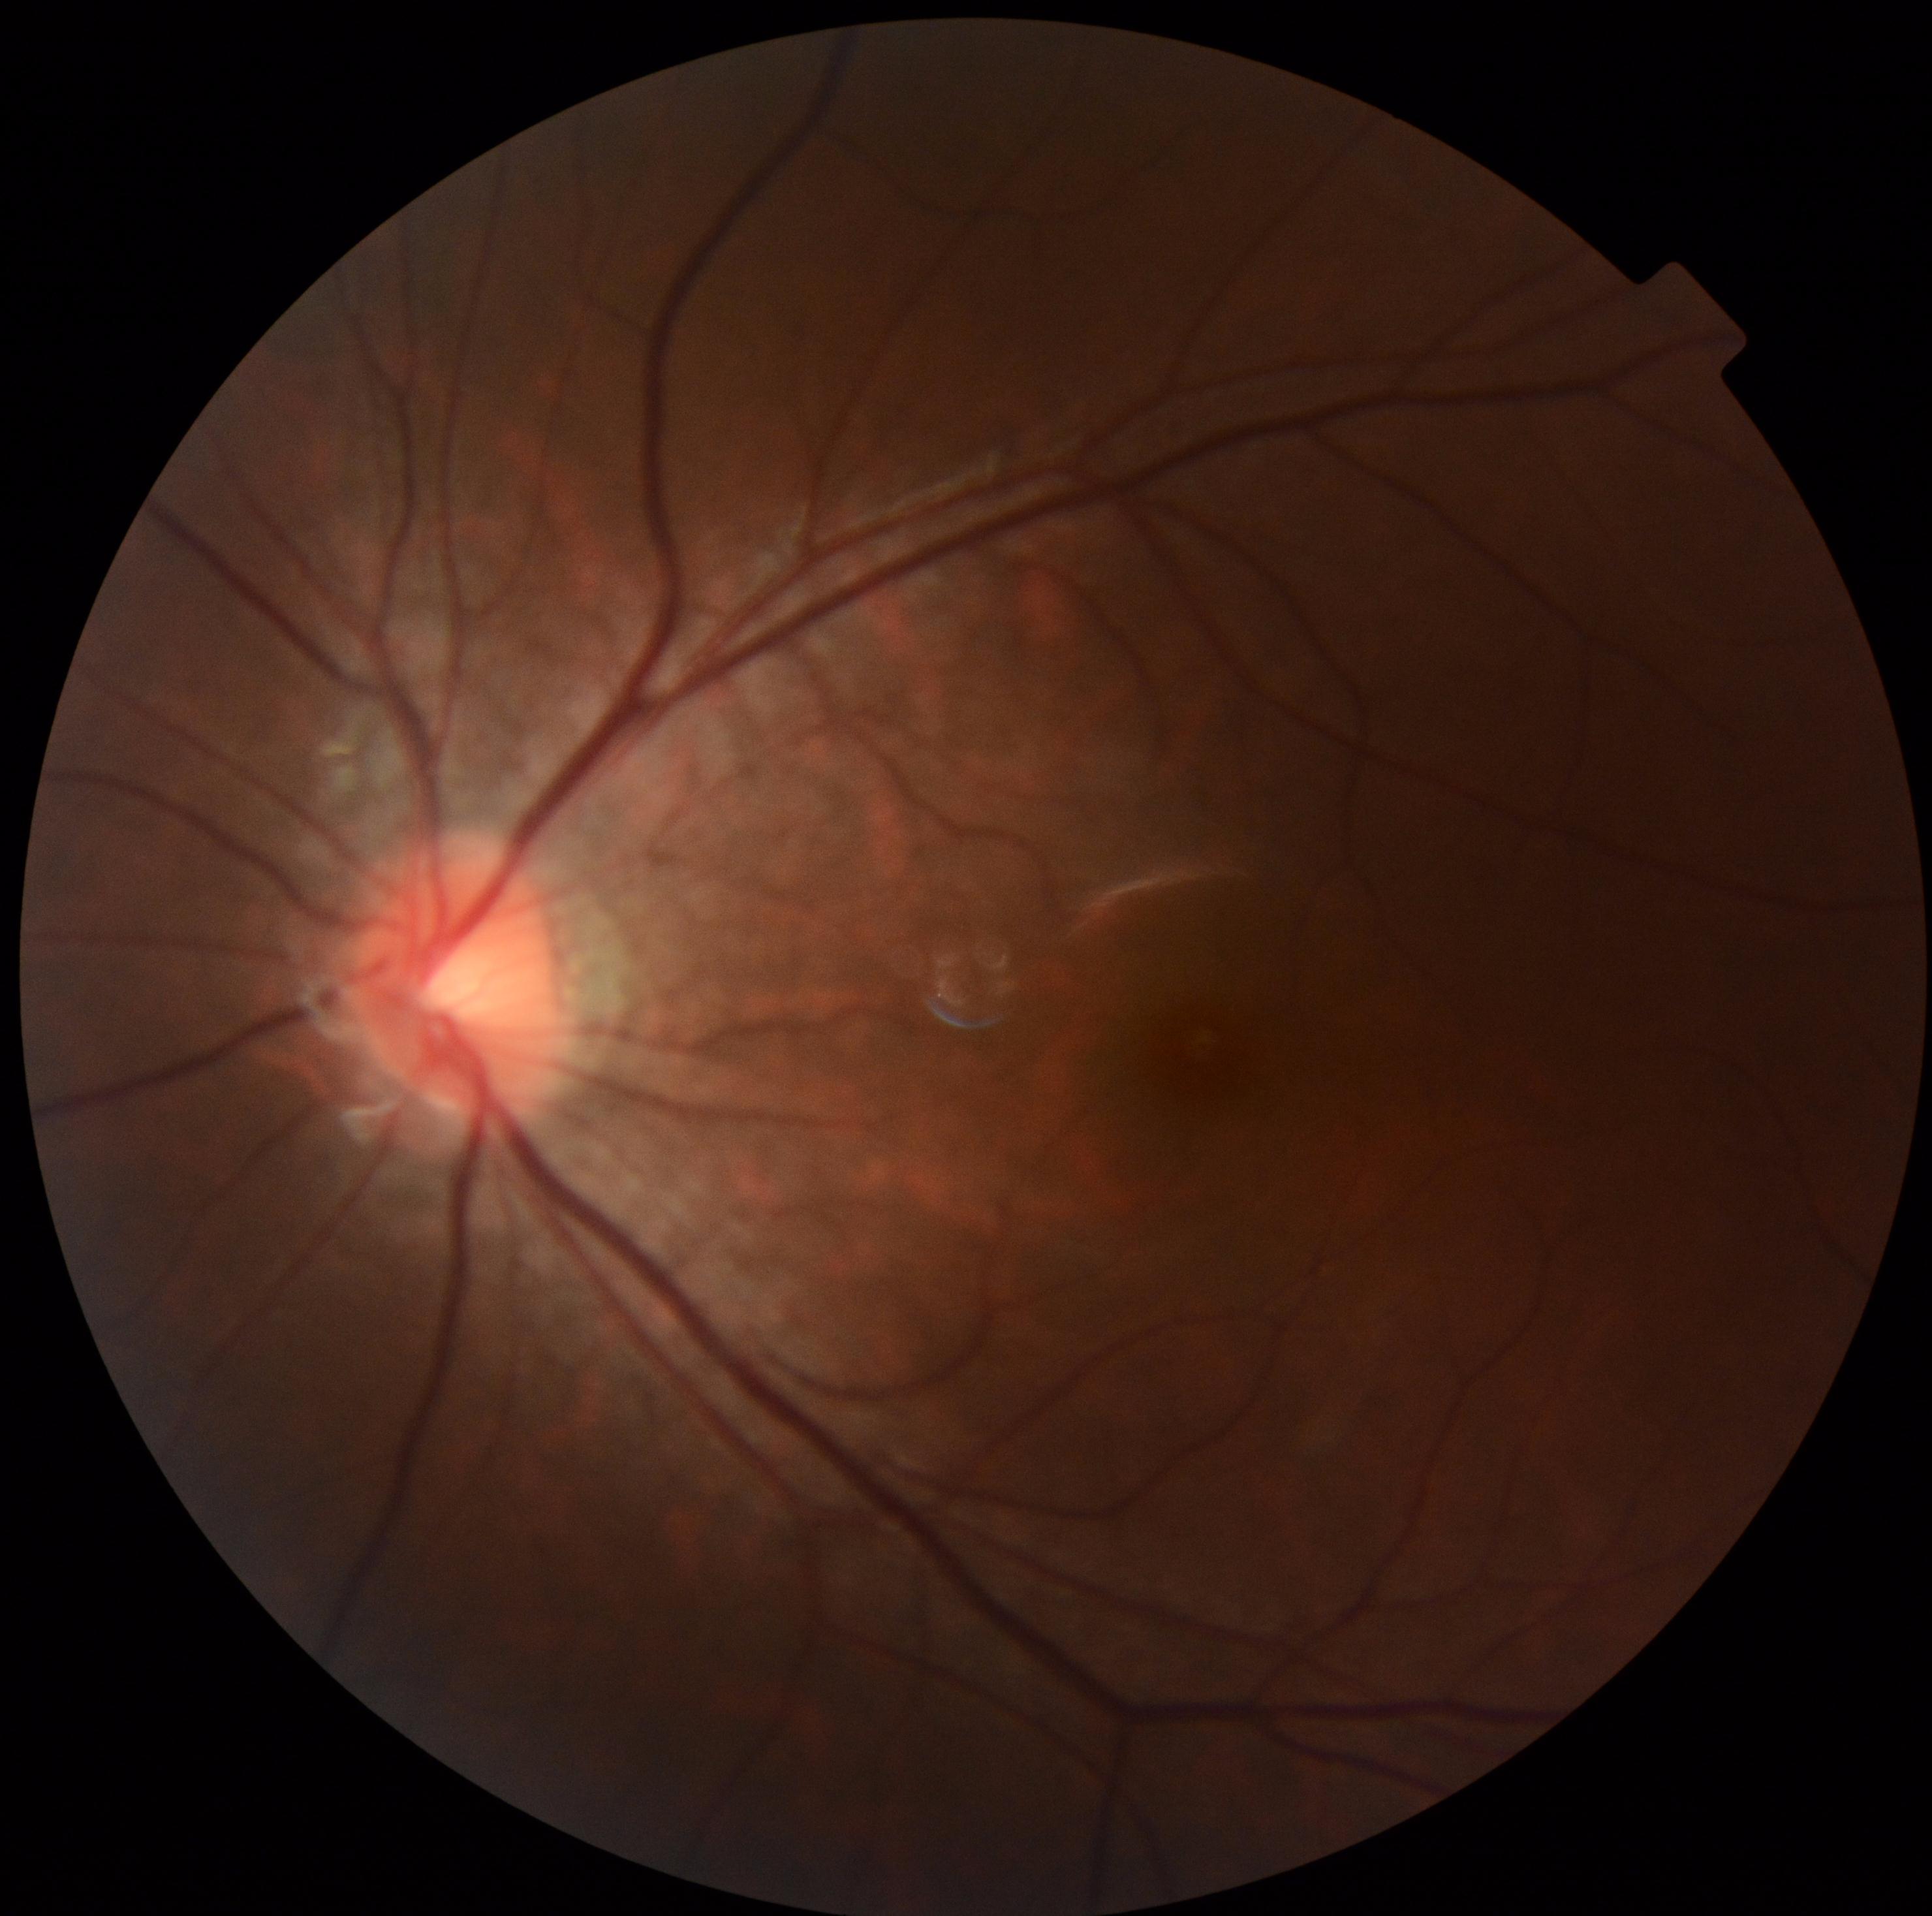
dr_impression: negative for DR
dr_grade: 0